Image size 848x848 — 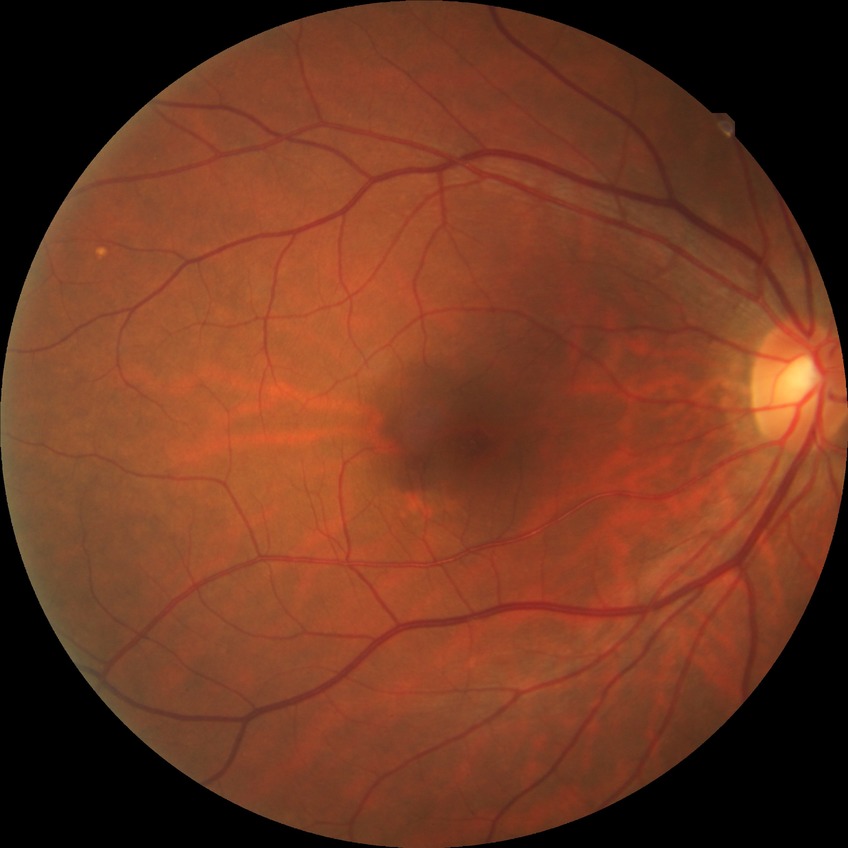

Diabetic retinopathy (DR) is NDR (no diabetic retinopathy).